FOV: 45 degrees: 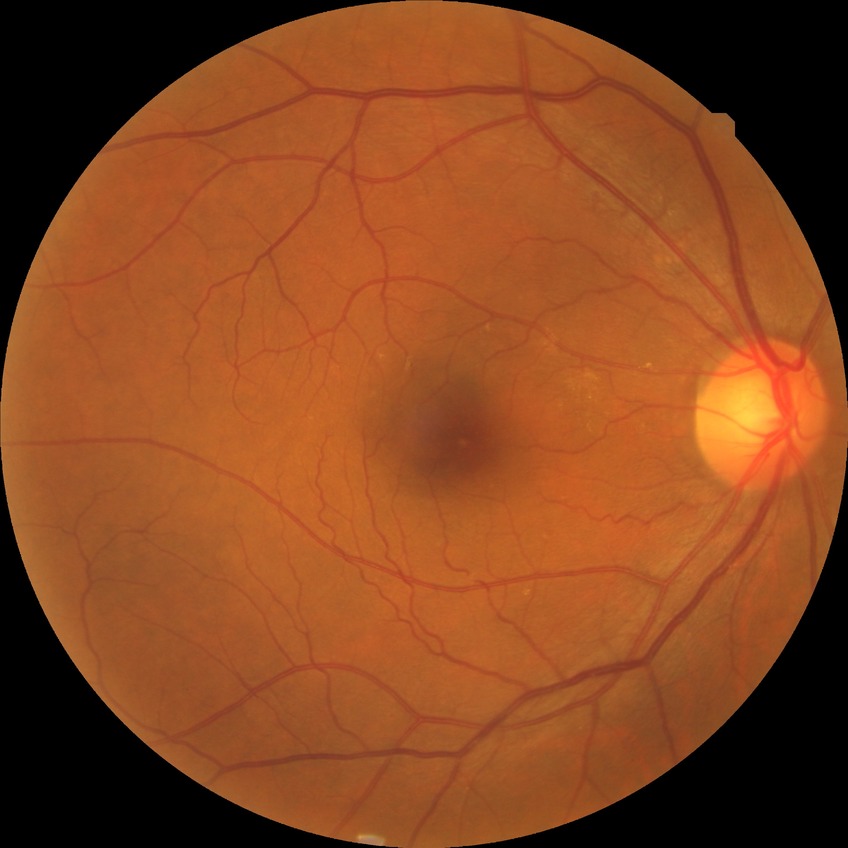

Diabetic retinopathy (DR) is simple diabetic retinopathy (SDR).